Wide-field fundus image from infant ROP screening; 640 x 480 pixels; 130° field of view (Clarity RetCam 3).
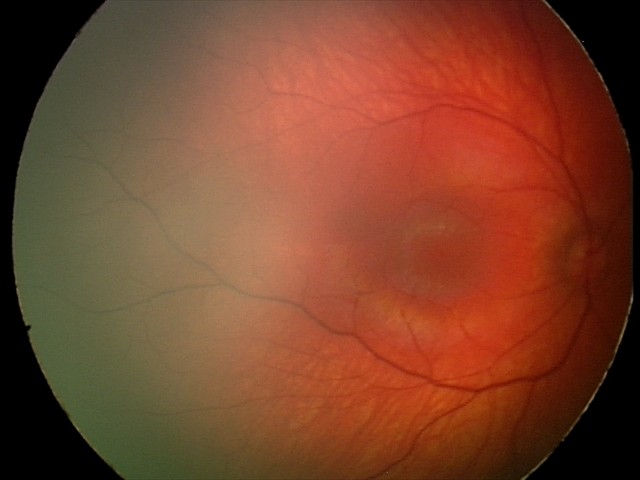

Normal screening examination.